Acquired with a Topcon TRC-50DX, 50° FOV, field includes the optic disc and macula: 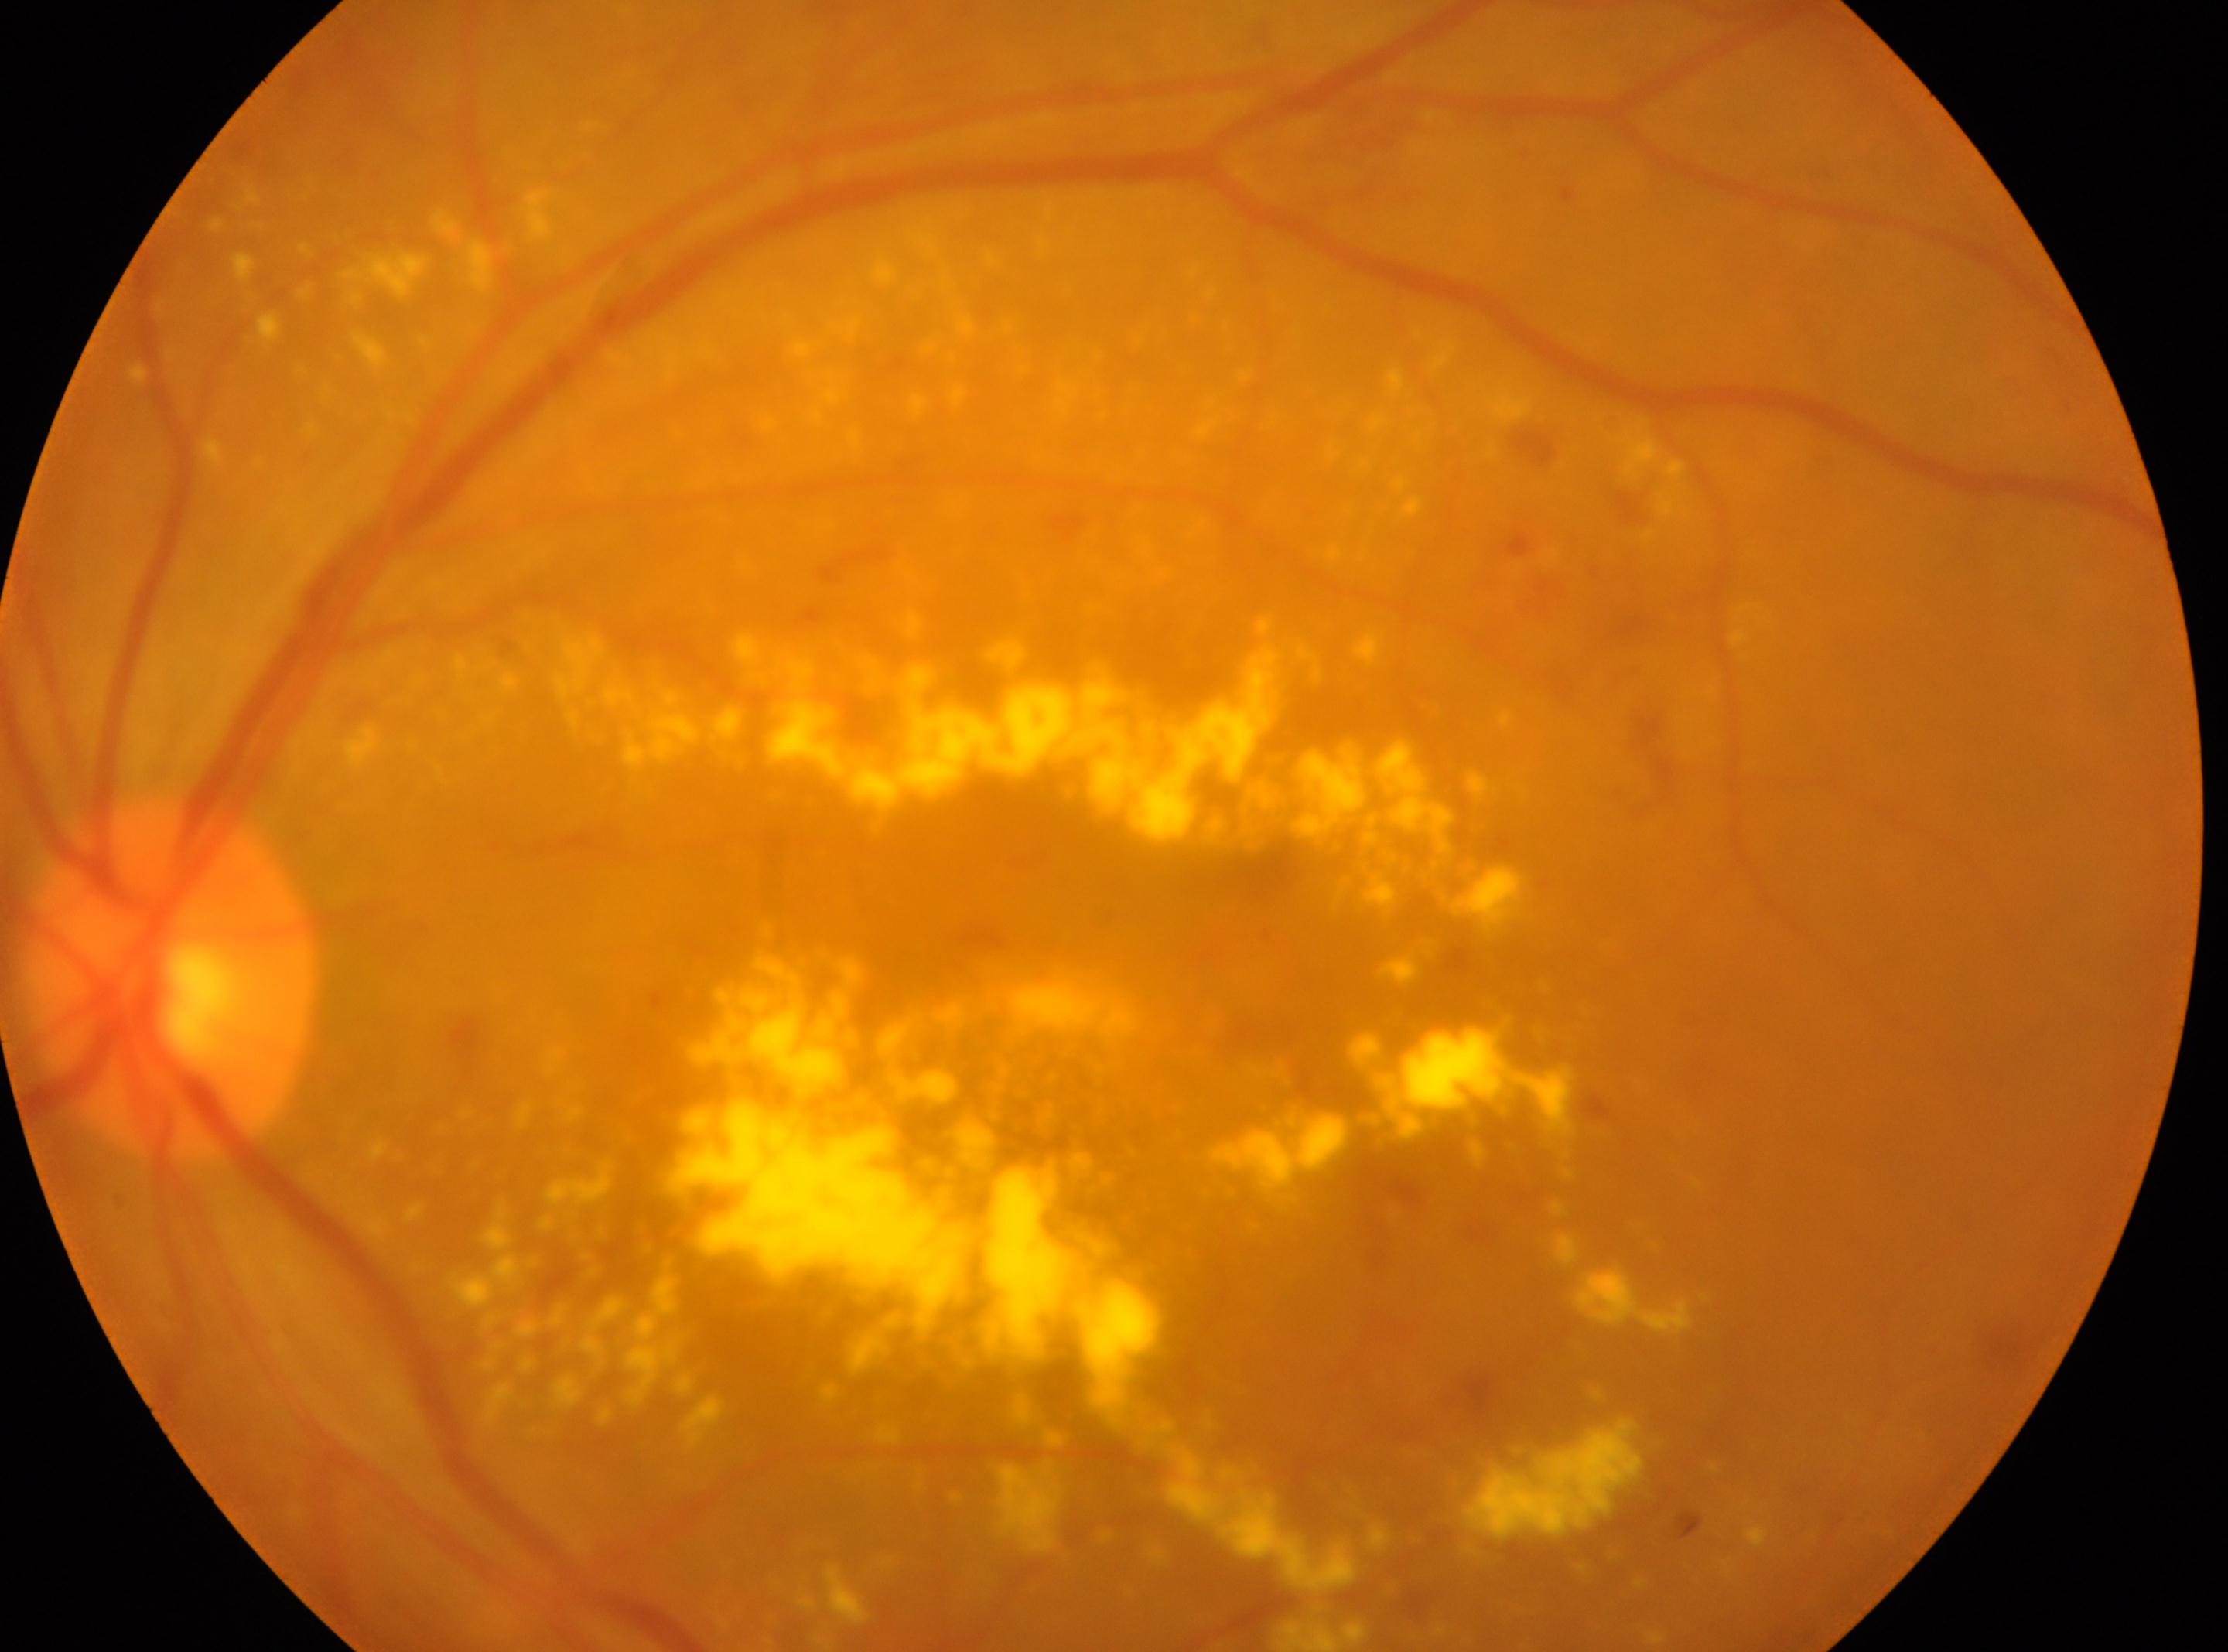
Findings:
• the fovea — 1010px, 1128px
• DR class — non-proliferative diabetic retinopathy
• optic nerve head — 169px, 978px
• DR — moderate non-proliferative diabetic retinopathy (grade 2) — more than just microaneurysms but less than severe NPDR
• laterality — left eye